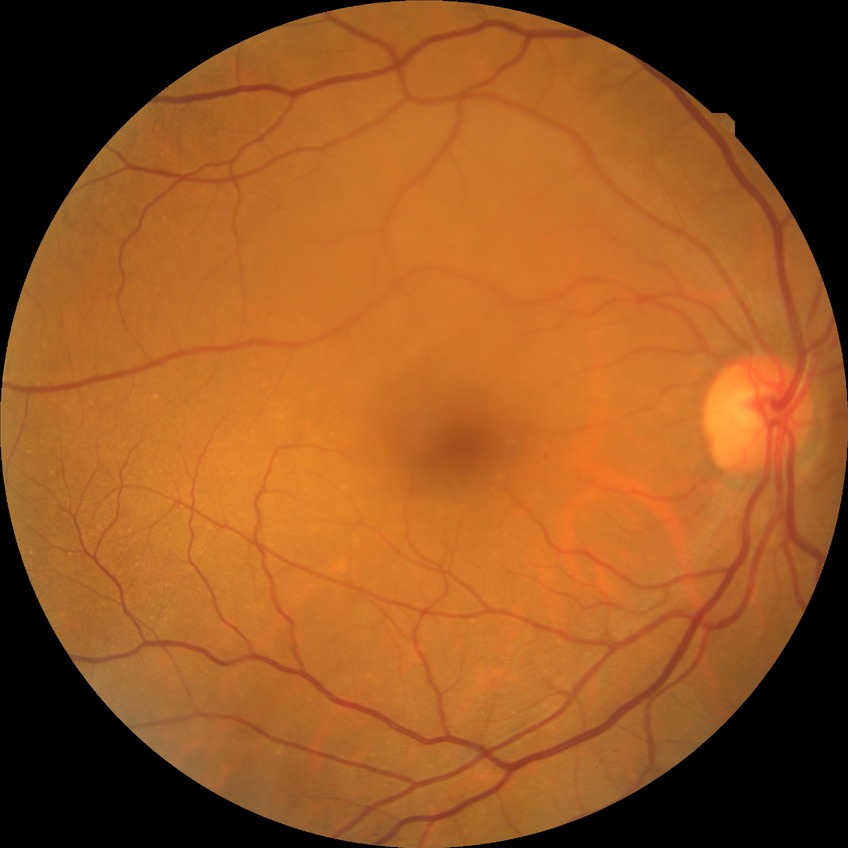 Diabetic retinopathy (DR) is no diabetic retinopathy (NDR).